Image size 2352x1568:
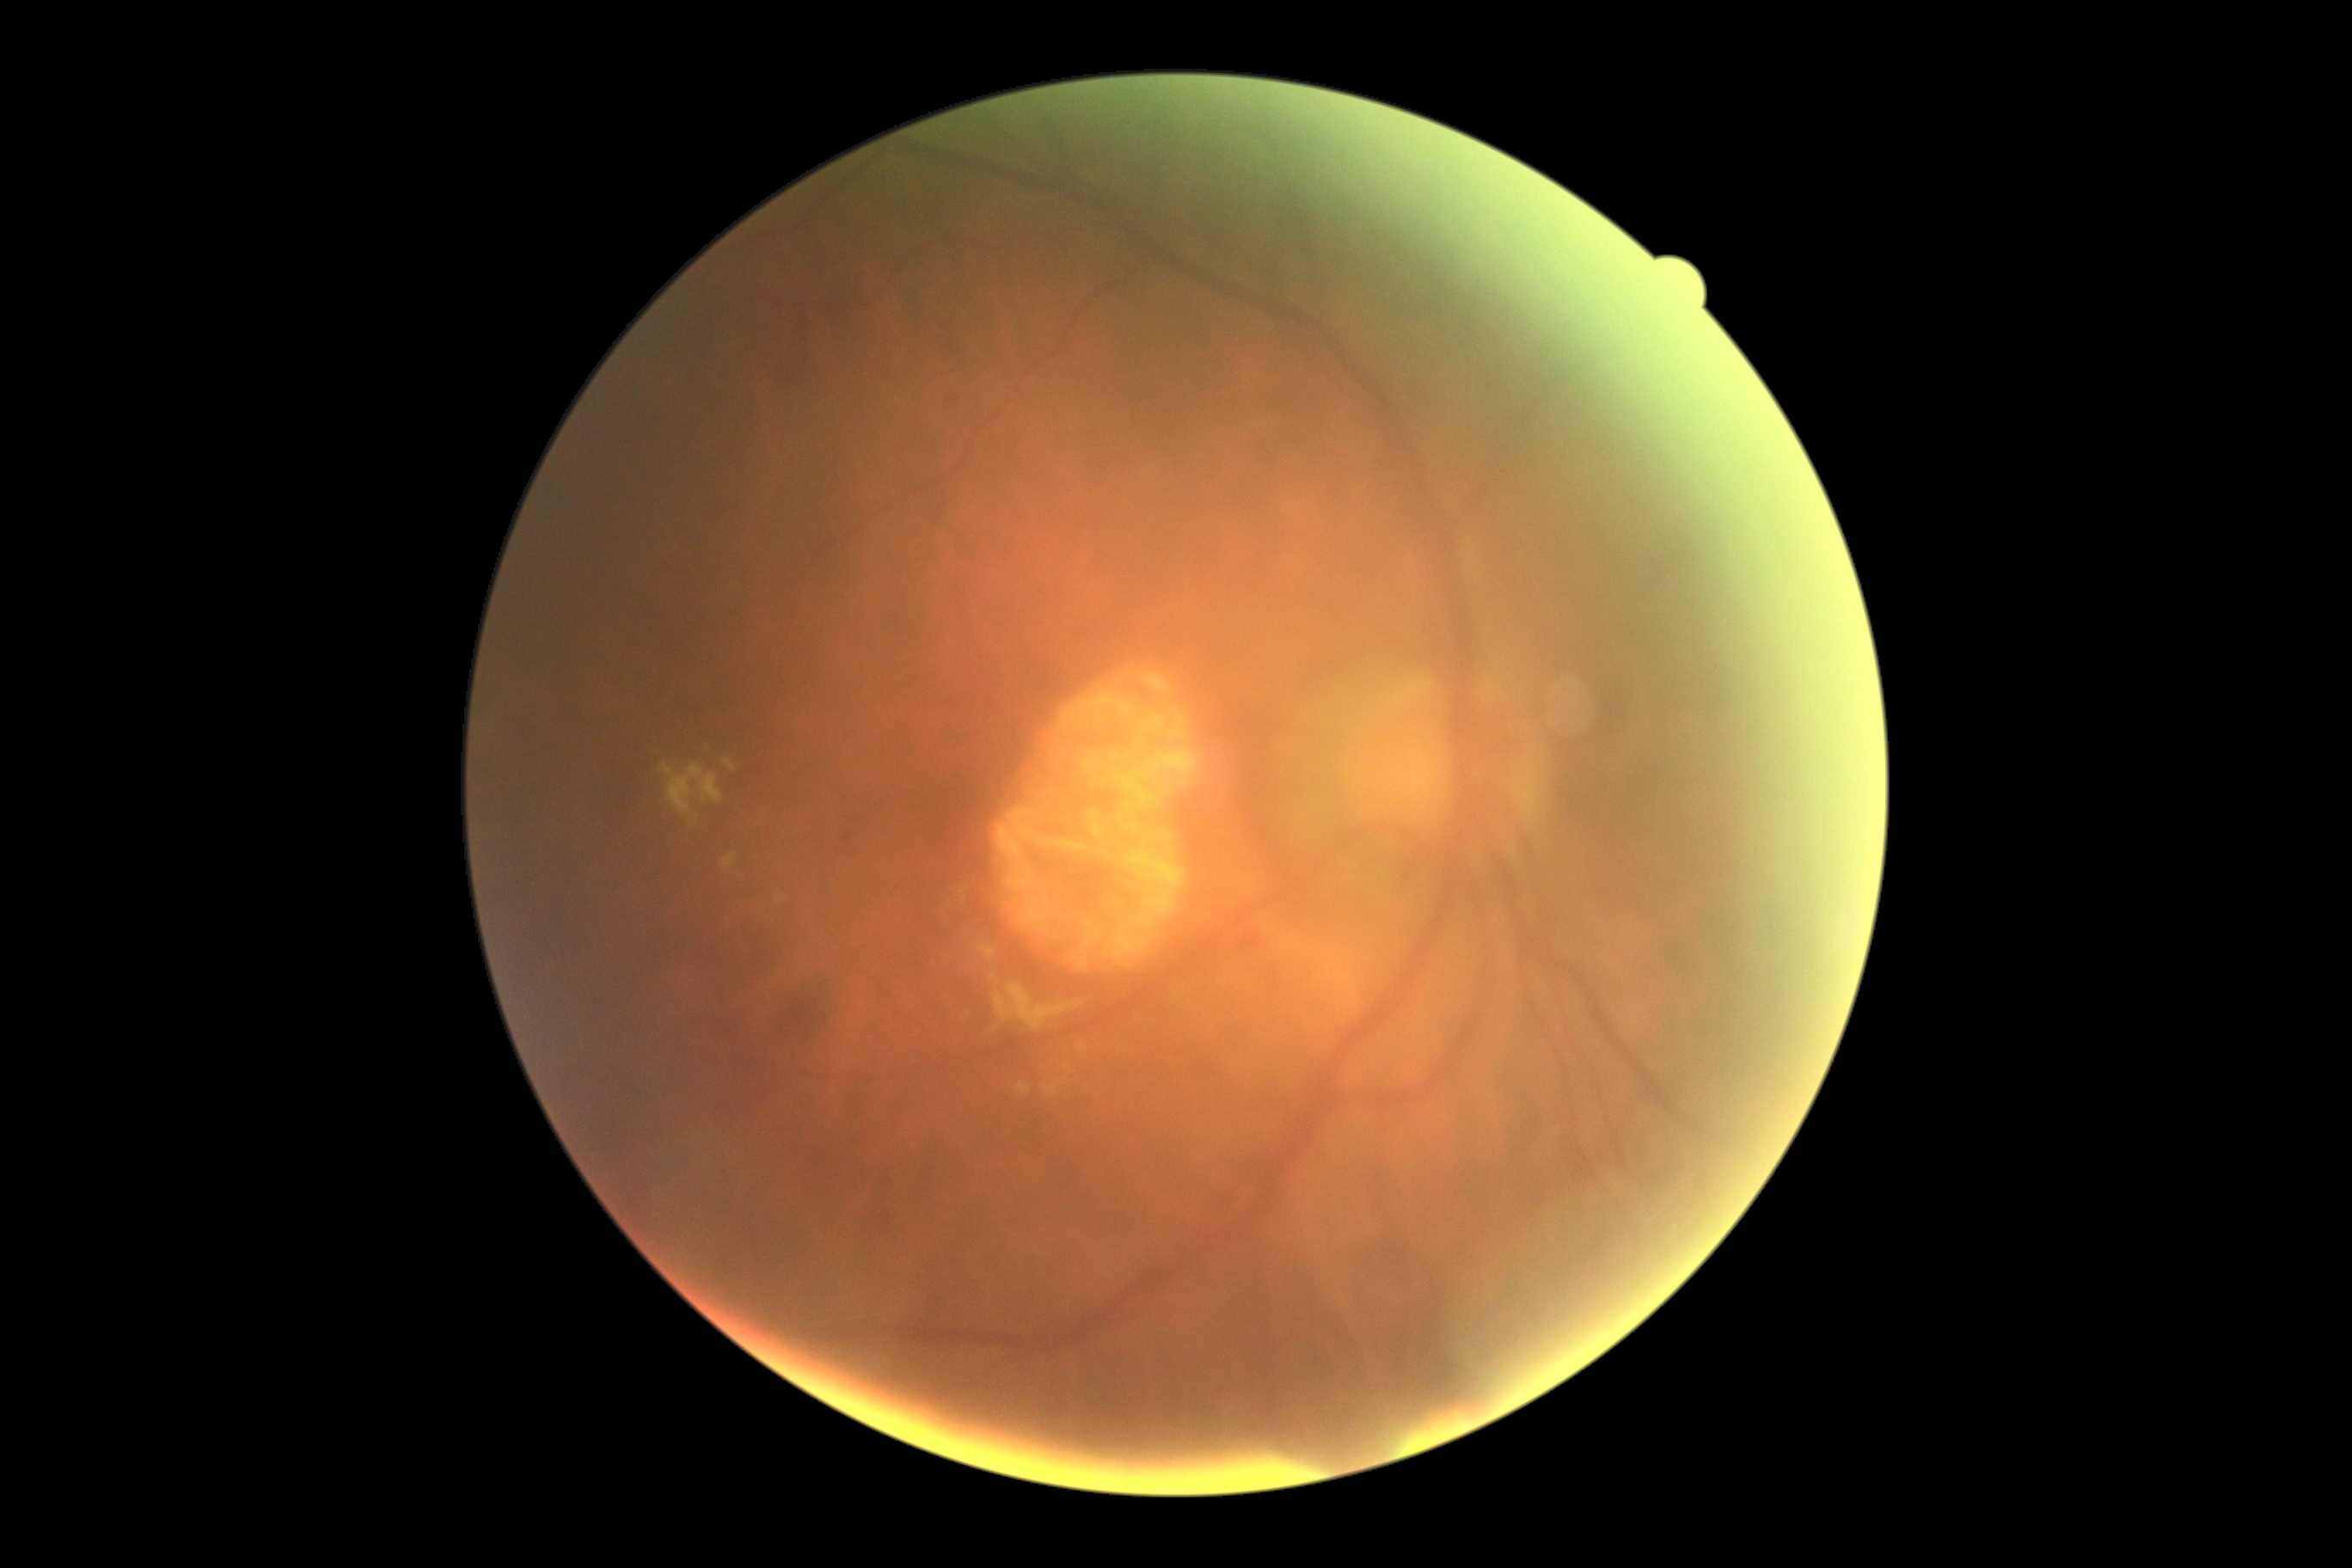
DR class@non-proliferative diabetic retinopathy, DR@grade 2 (moderate NPDR).